Pediatric wide-field fundus photograph — 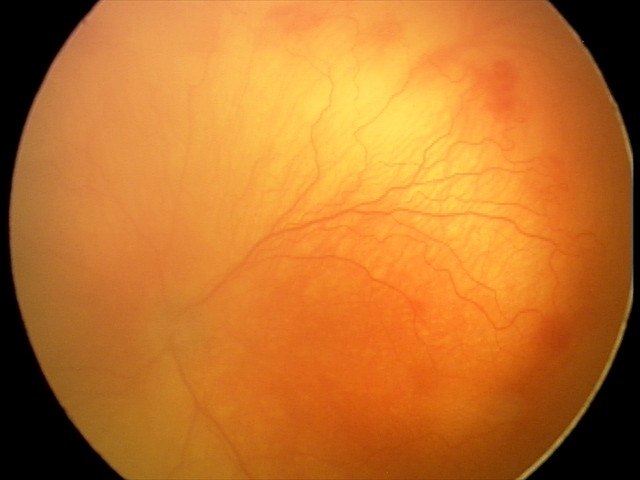 From an examination with diagnosis of aggressive retinopathy of prematurity — rapidly progressive severe ROP with prominent plus disease, often without classic stage progression. Plus disease was diagnosed.